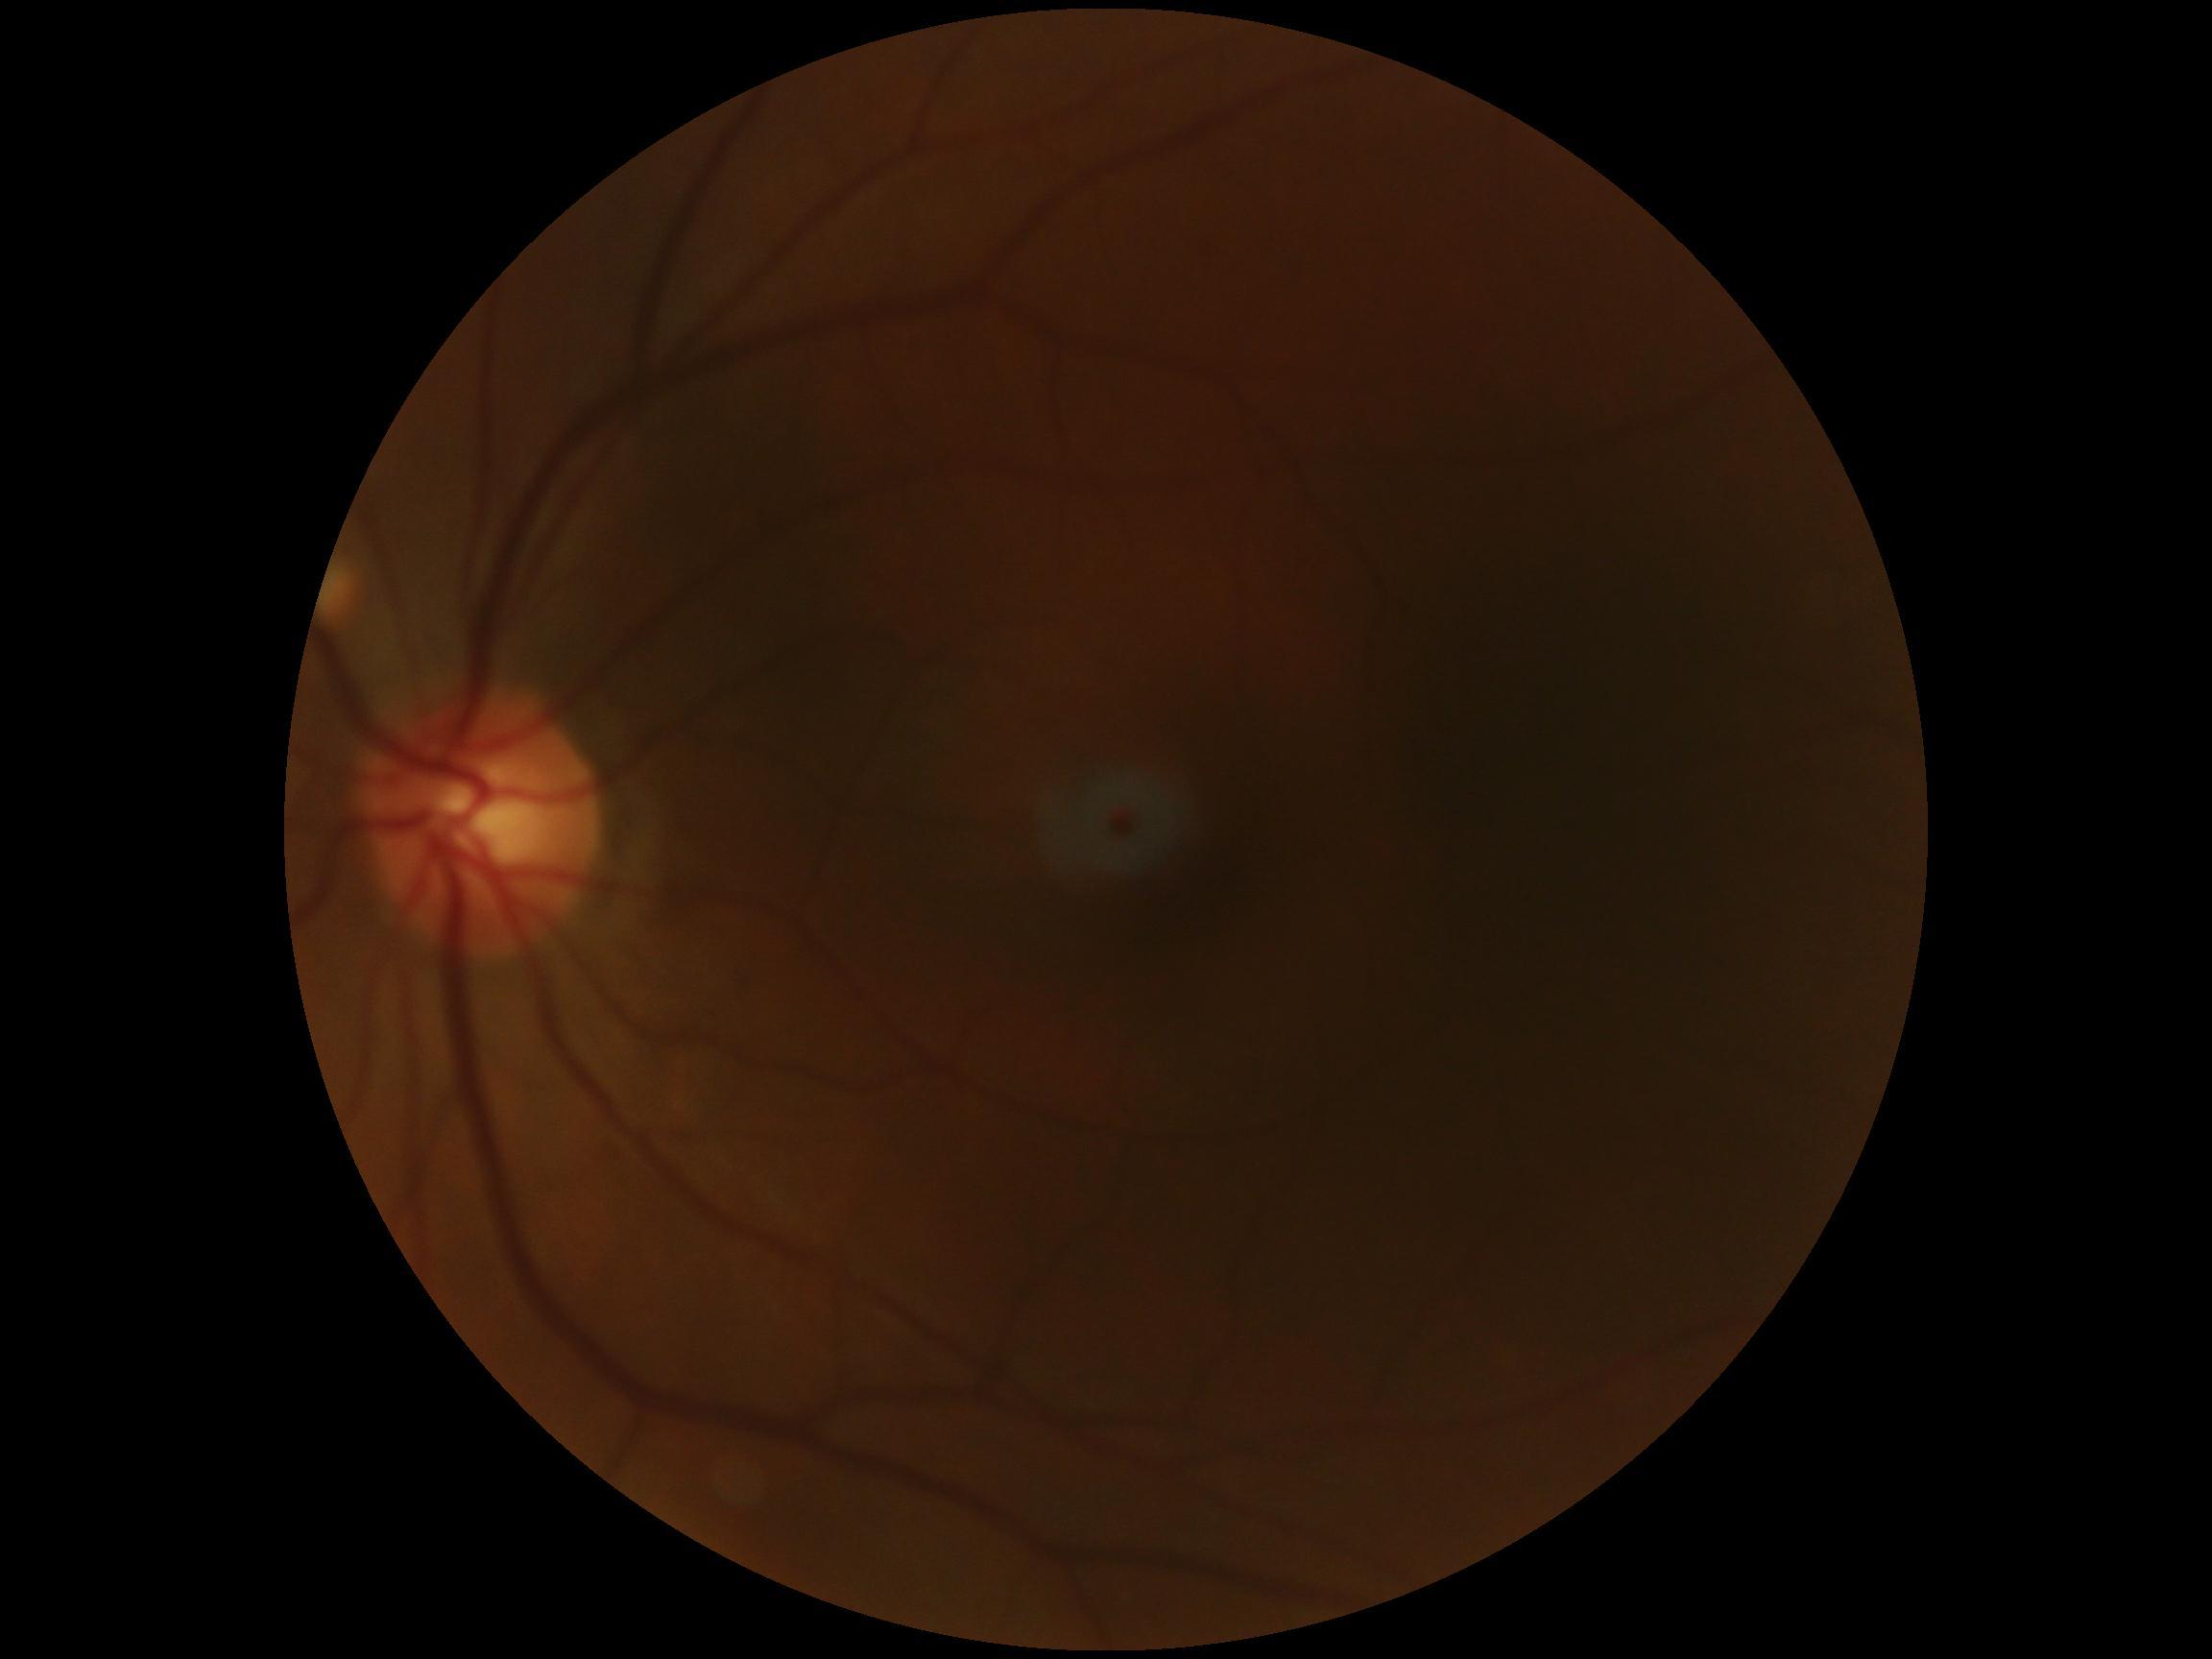 diabetic retinopathy grade: 0 (no apparent retinopathy) — no visible signs of diabetic retinopathy.